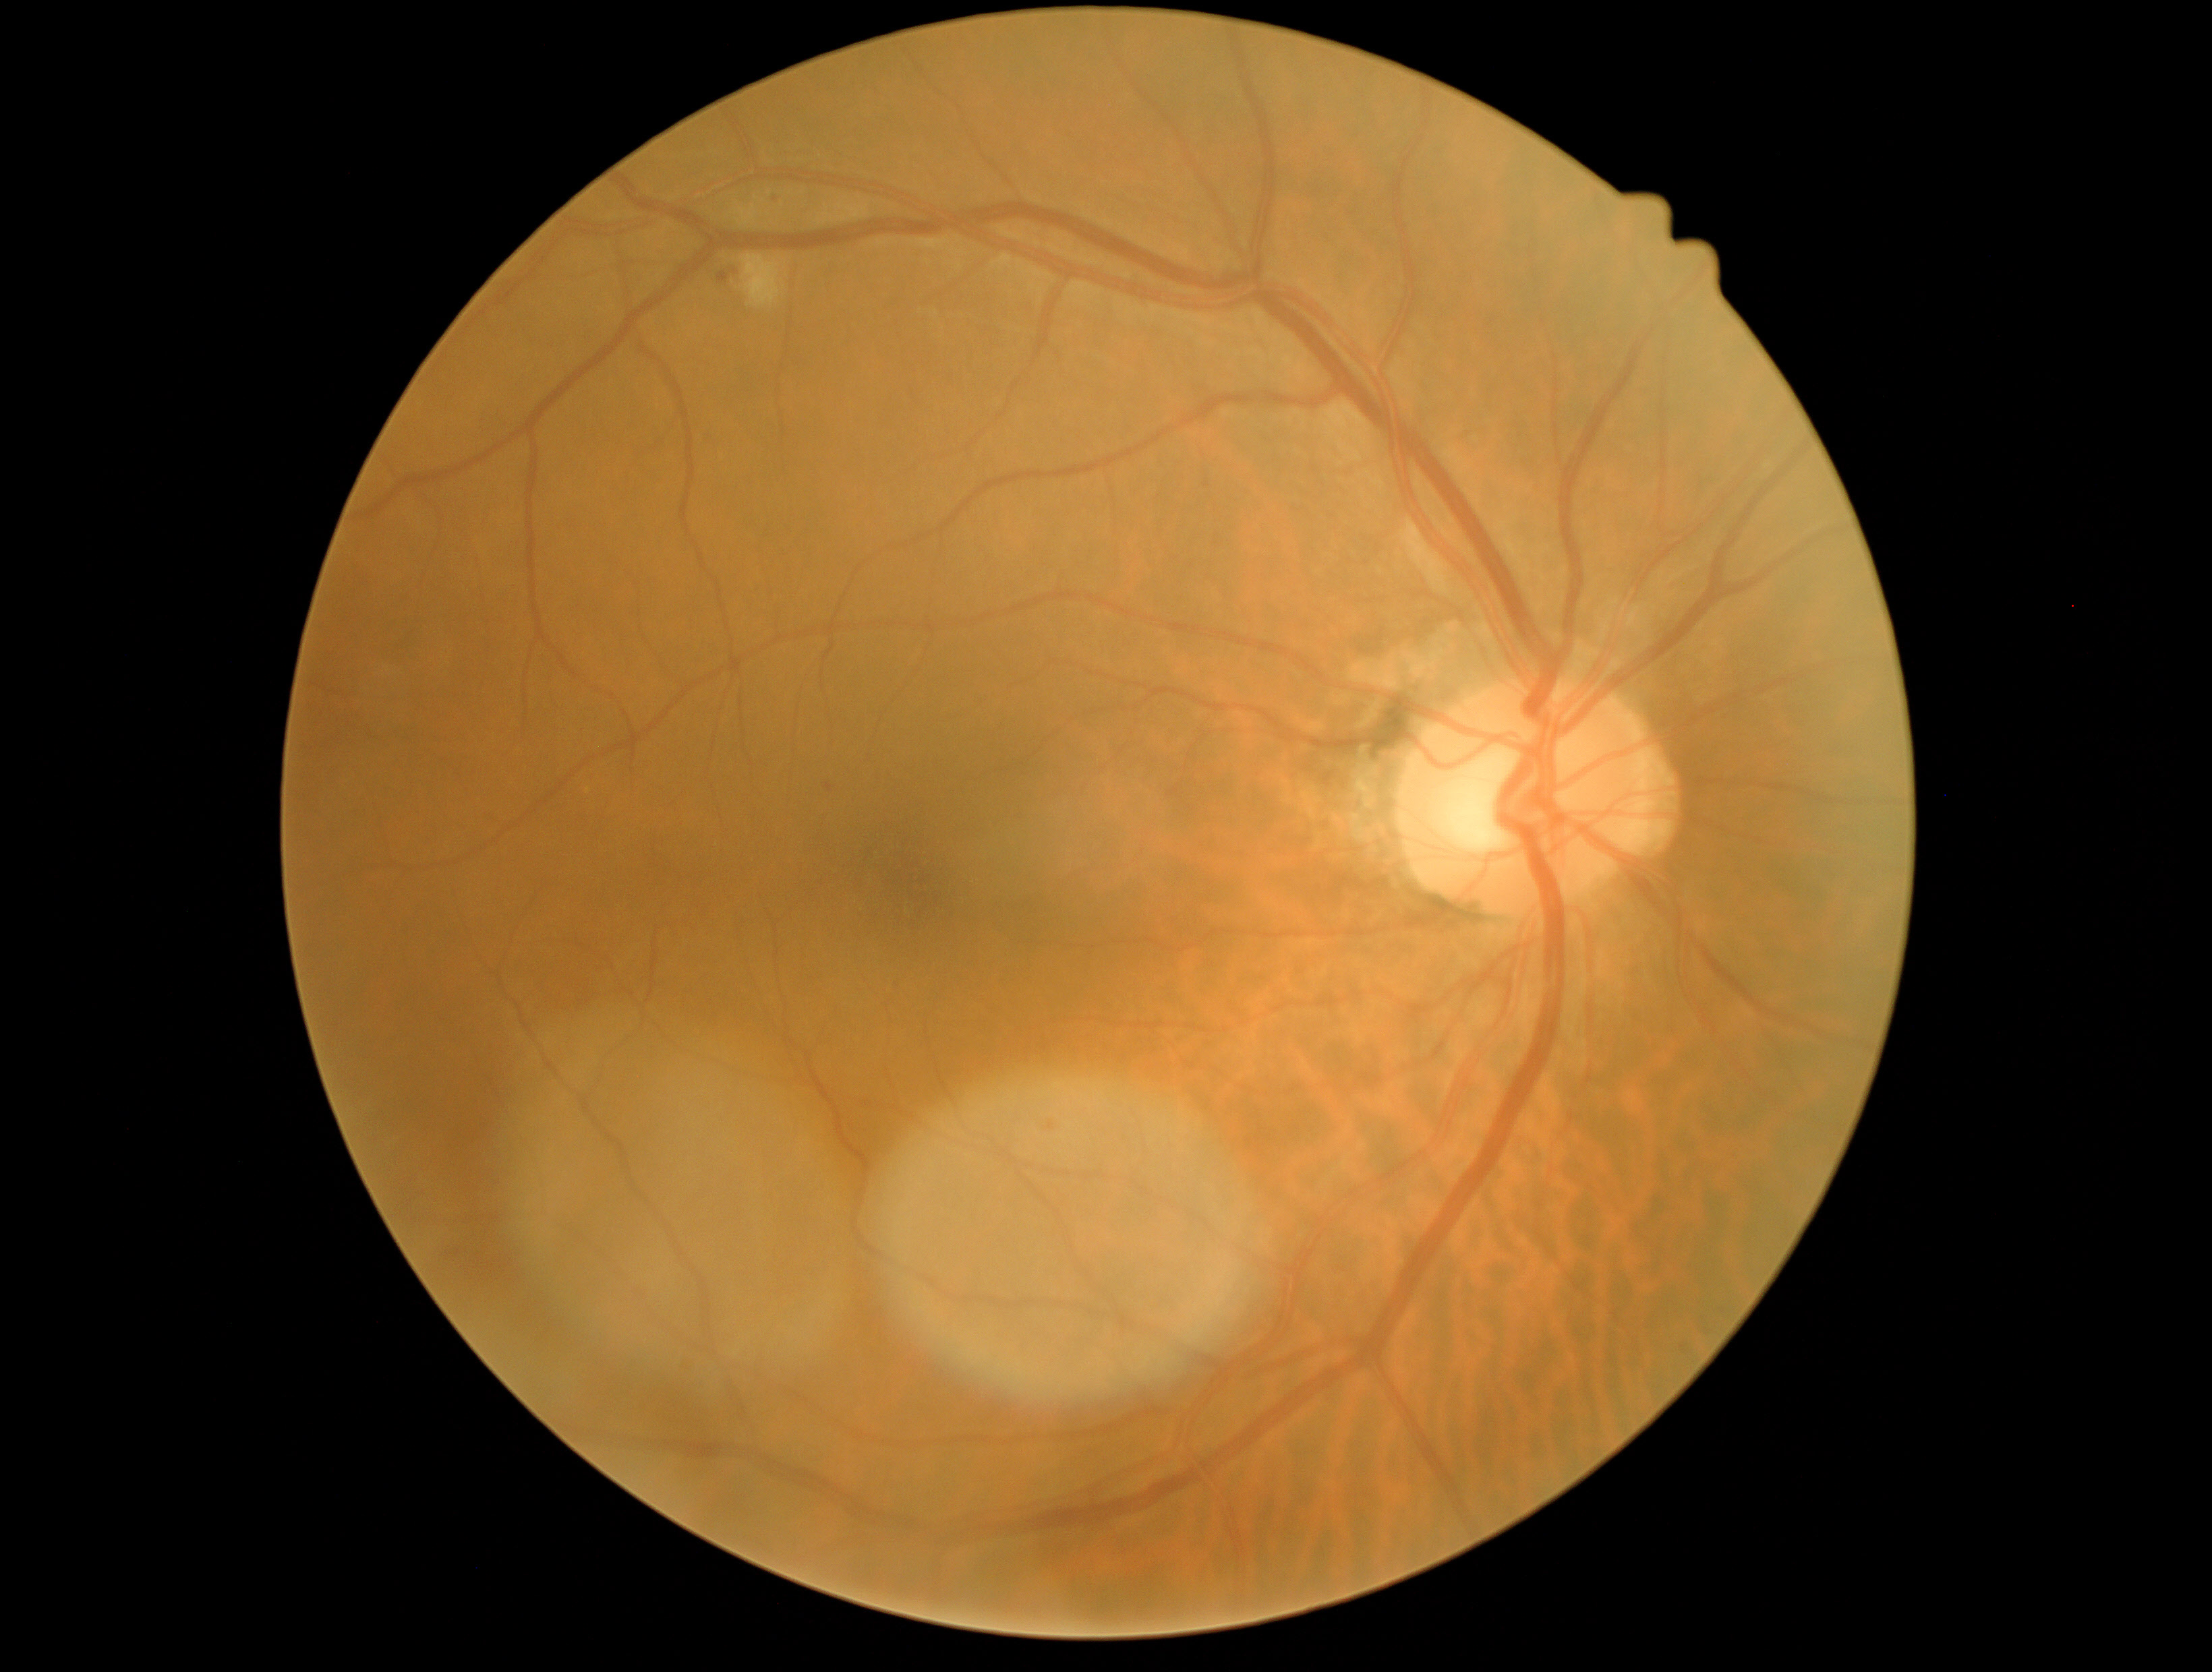
{"dr_grade": "moderate NPDR (grade 2)"}